1924 by 1556 pixels. Ultra-widefield fundus photograph
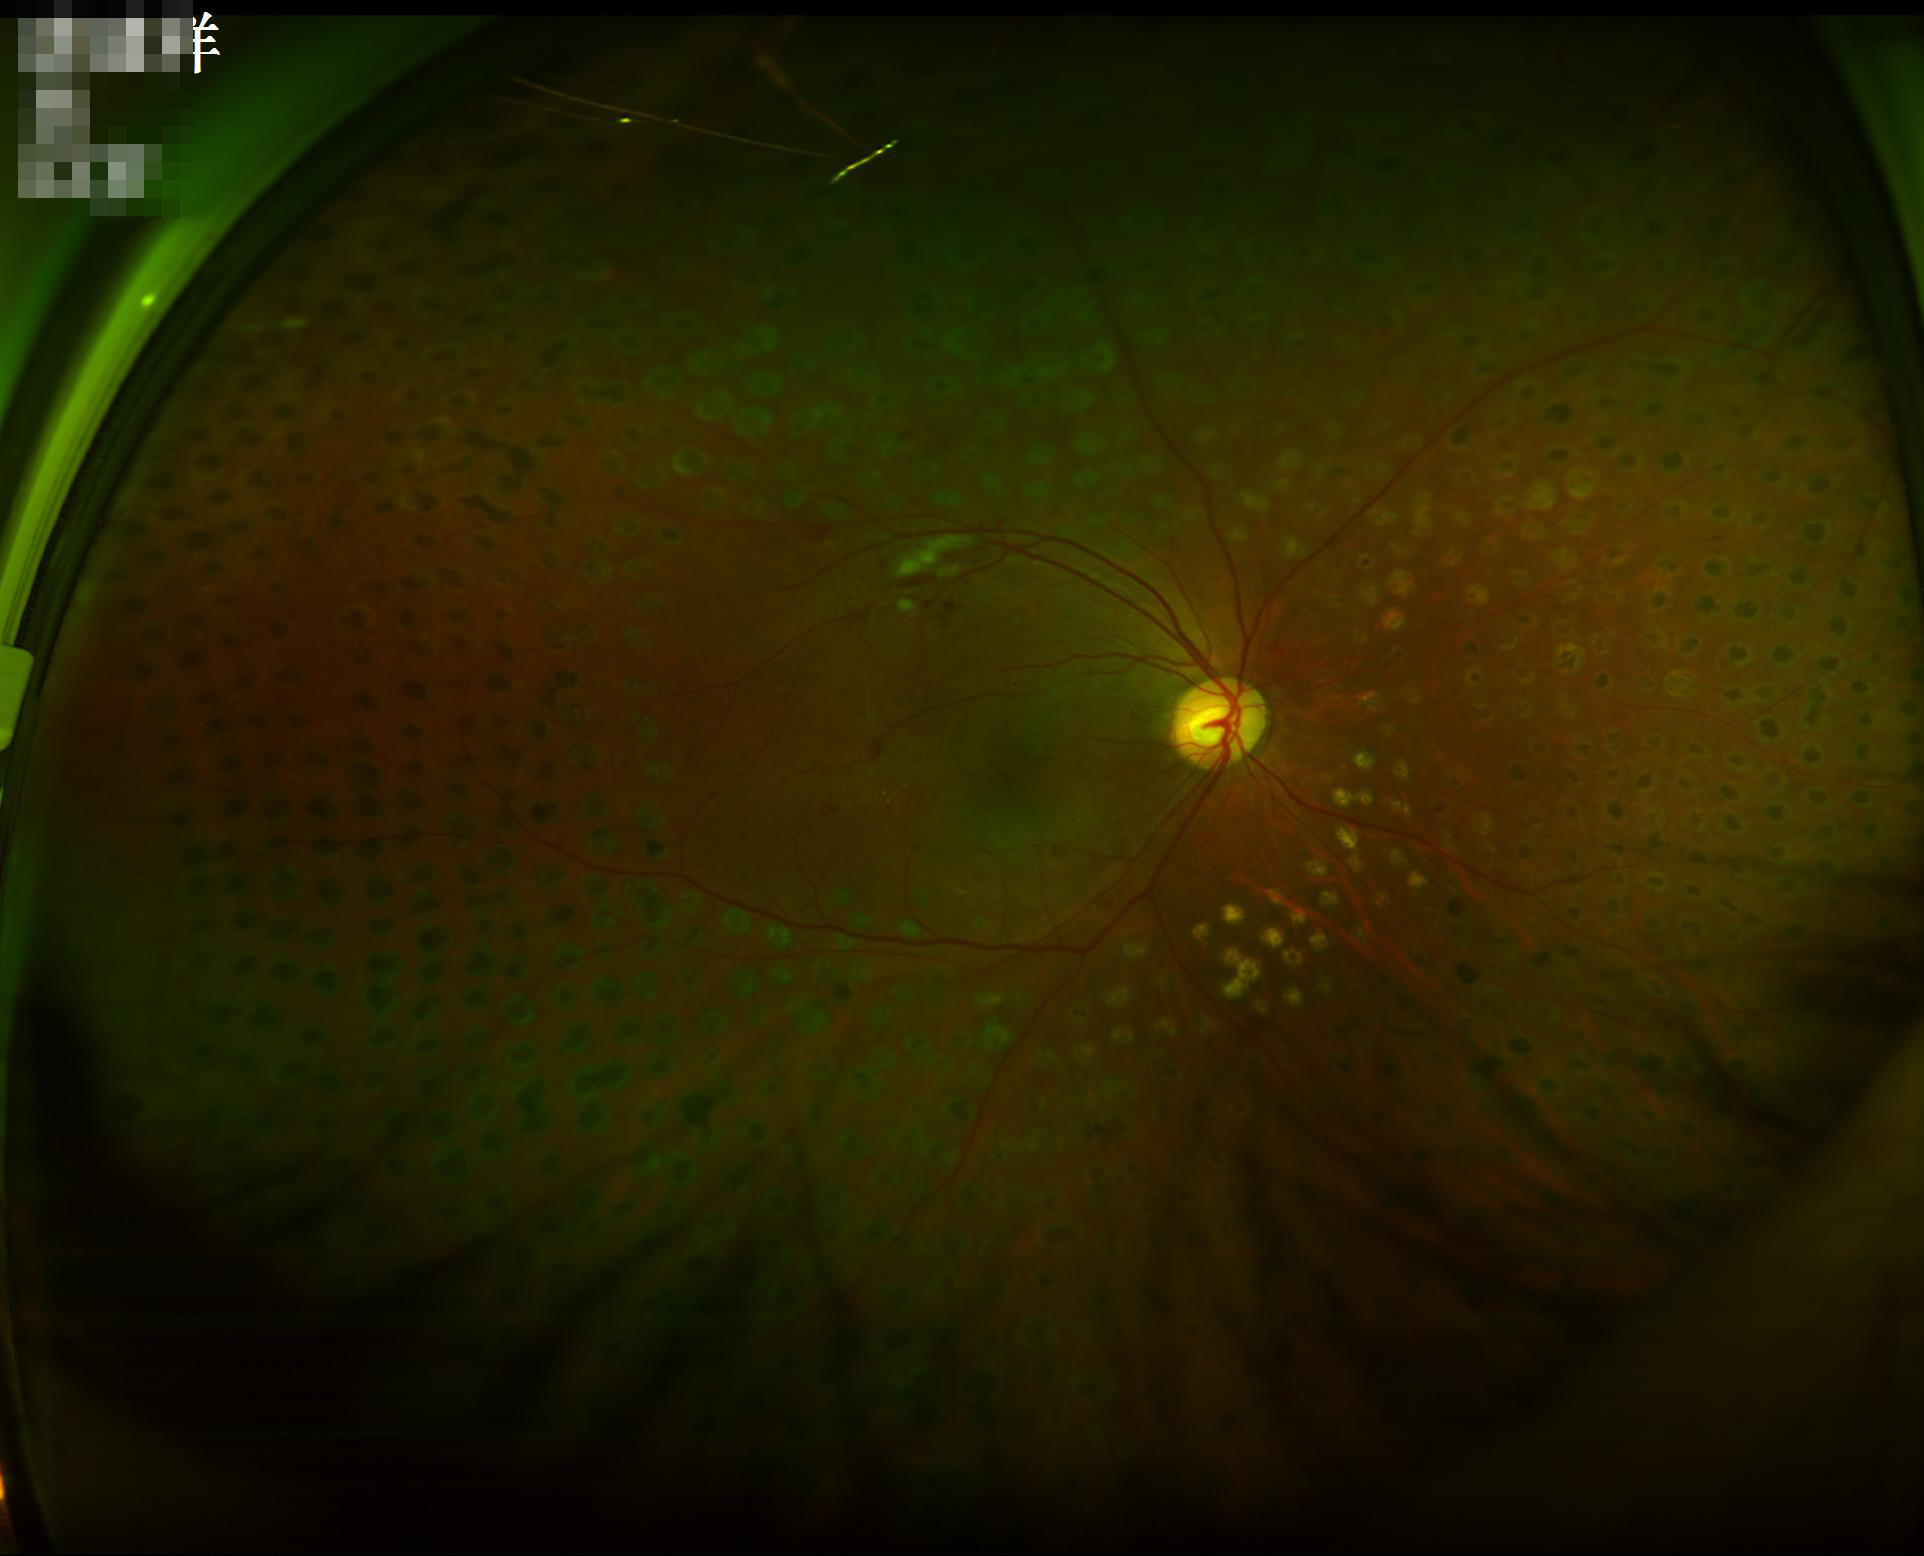
Poor illumination with uneven exposure. Contrast is good. Image is sharp throughout the field. Acceptable image quality.